Acquired with a Nidek AFC-330: 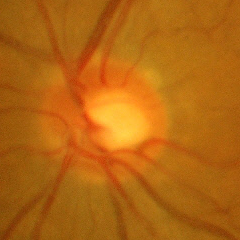

Q: Glaucoma assessment?
A: No glaucoma.